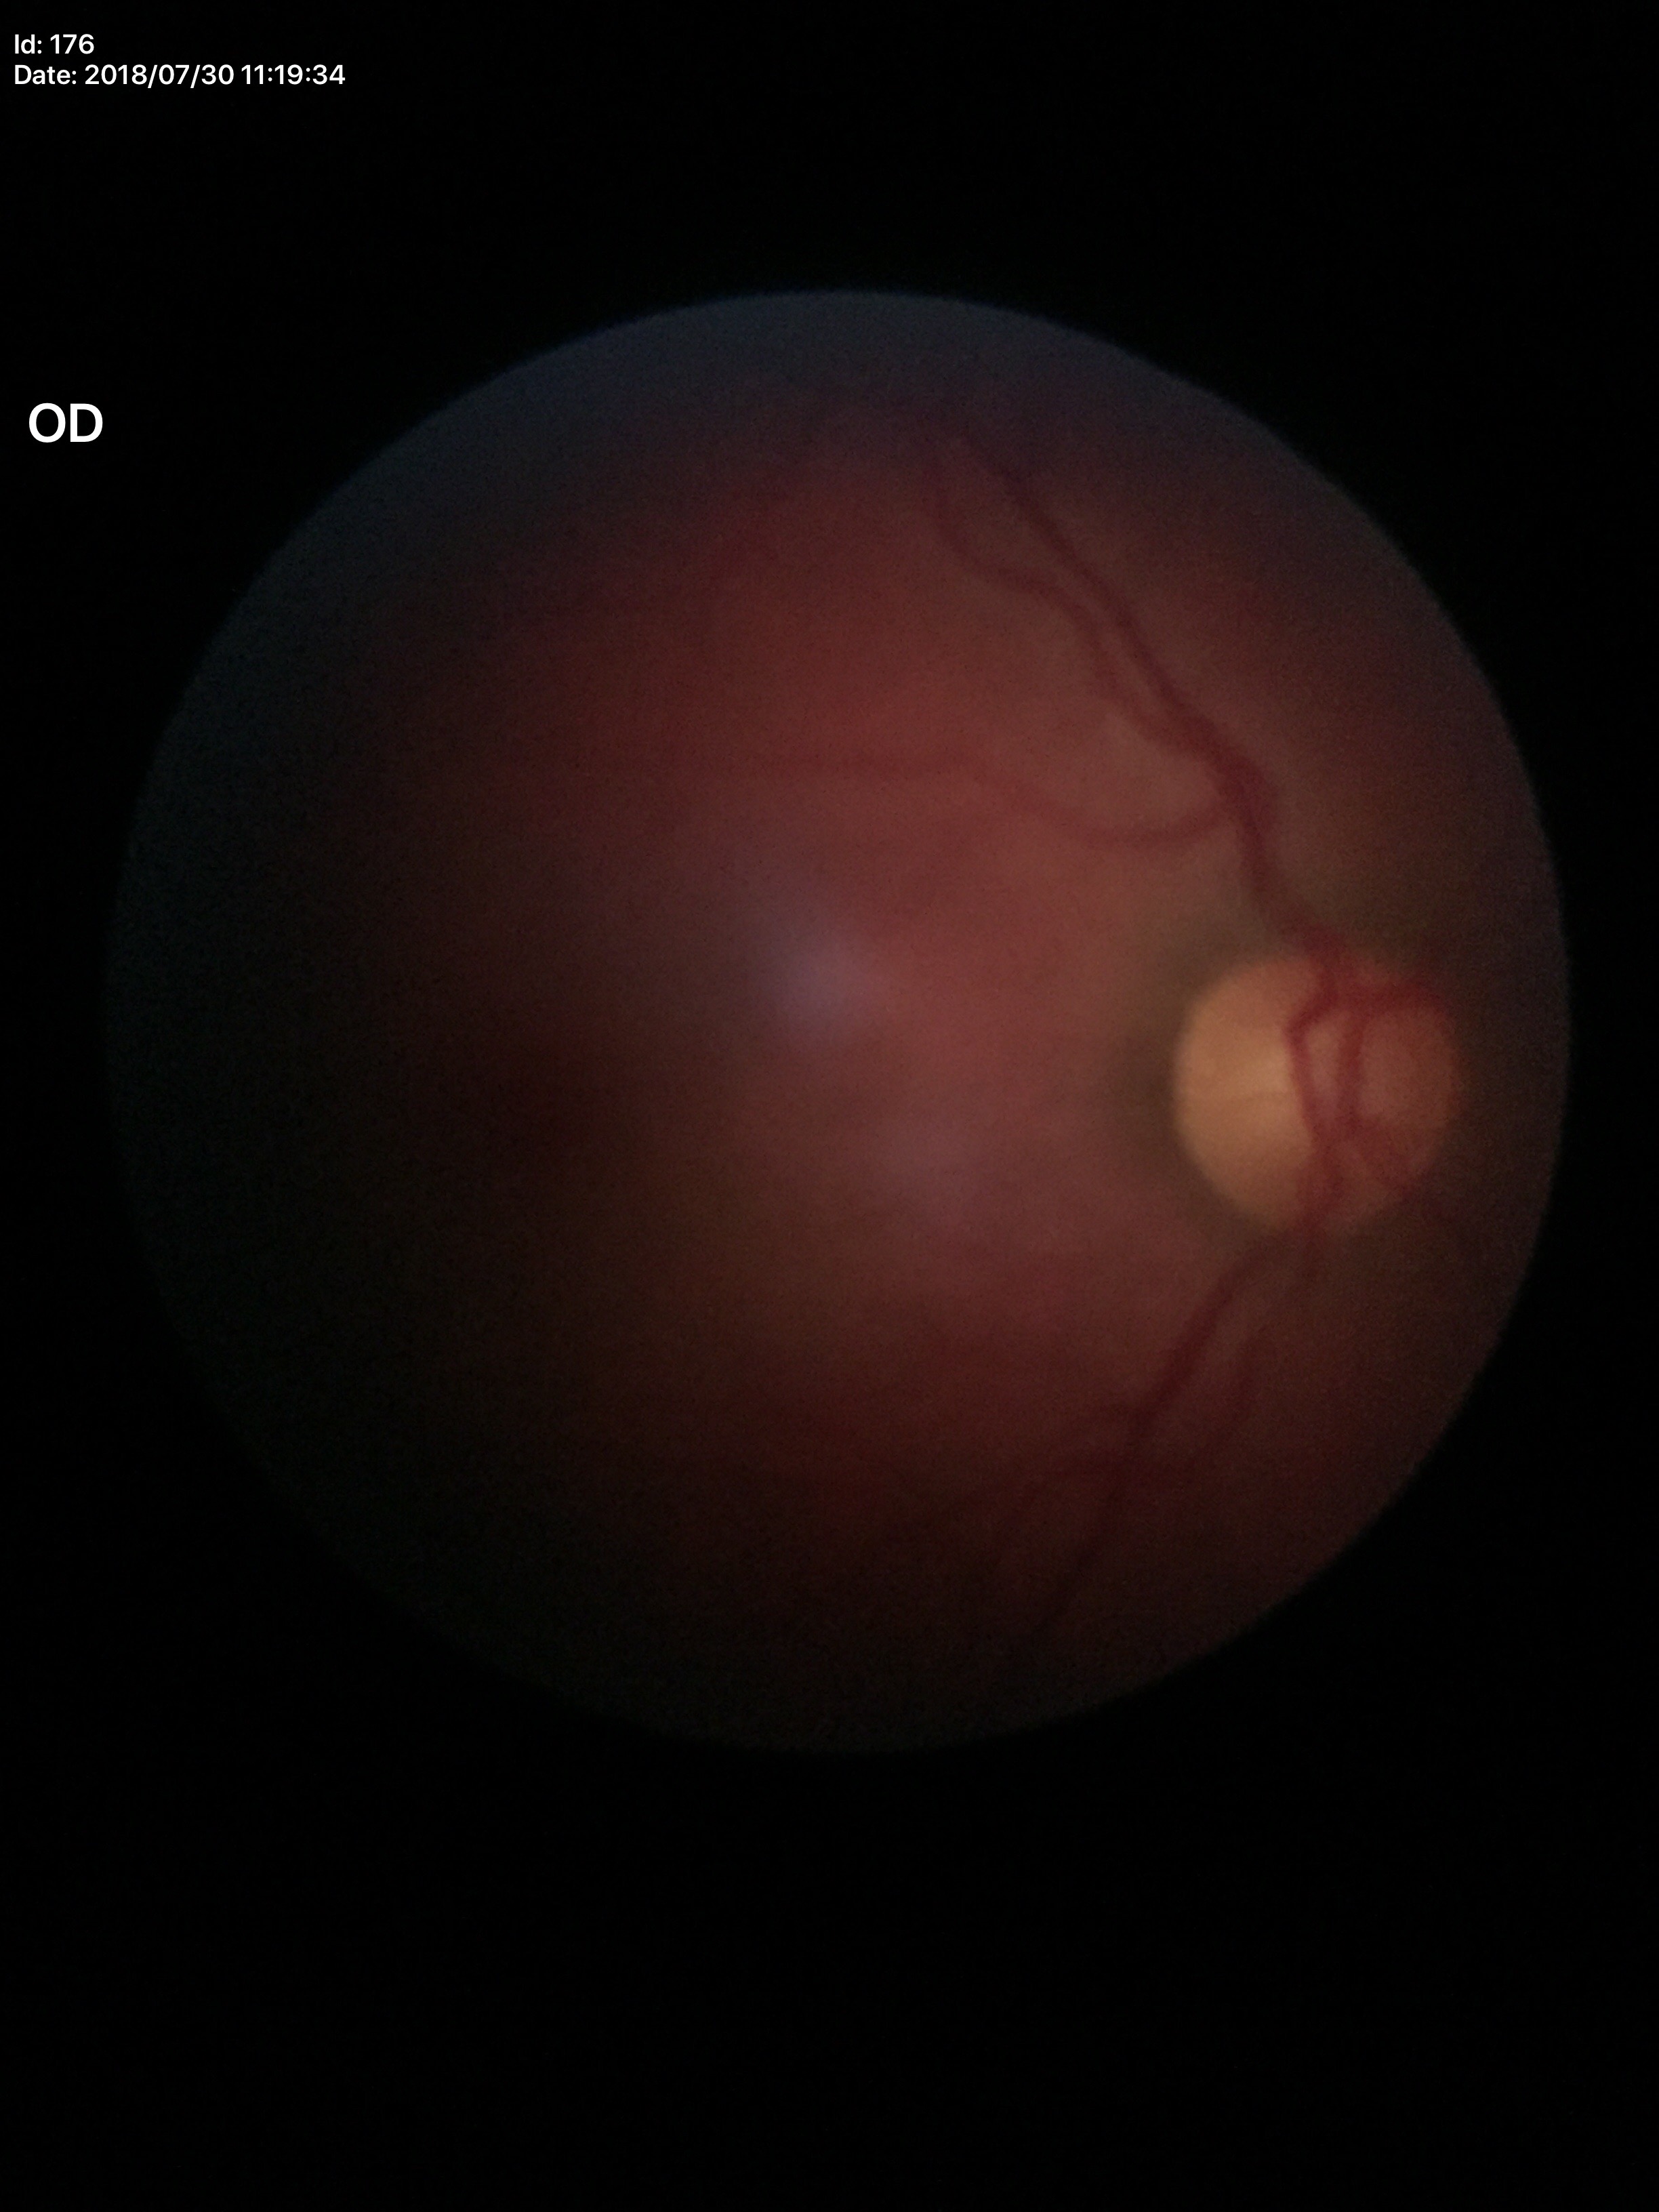

{"glaucoma_decision": "not suspect", "vcdr": "0.57", "acdr": "0.31", "hcdr": "0.55"}